Color fundus image
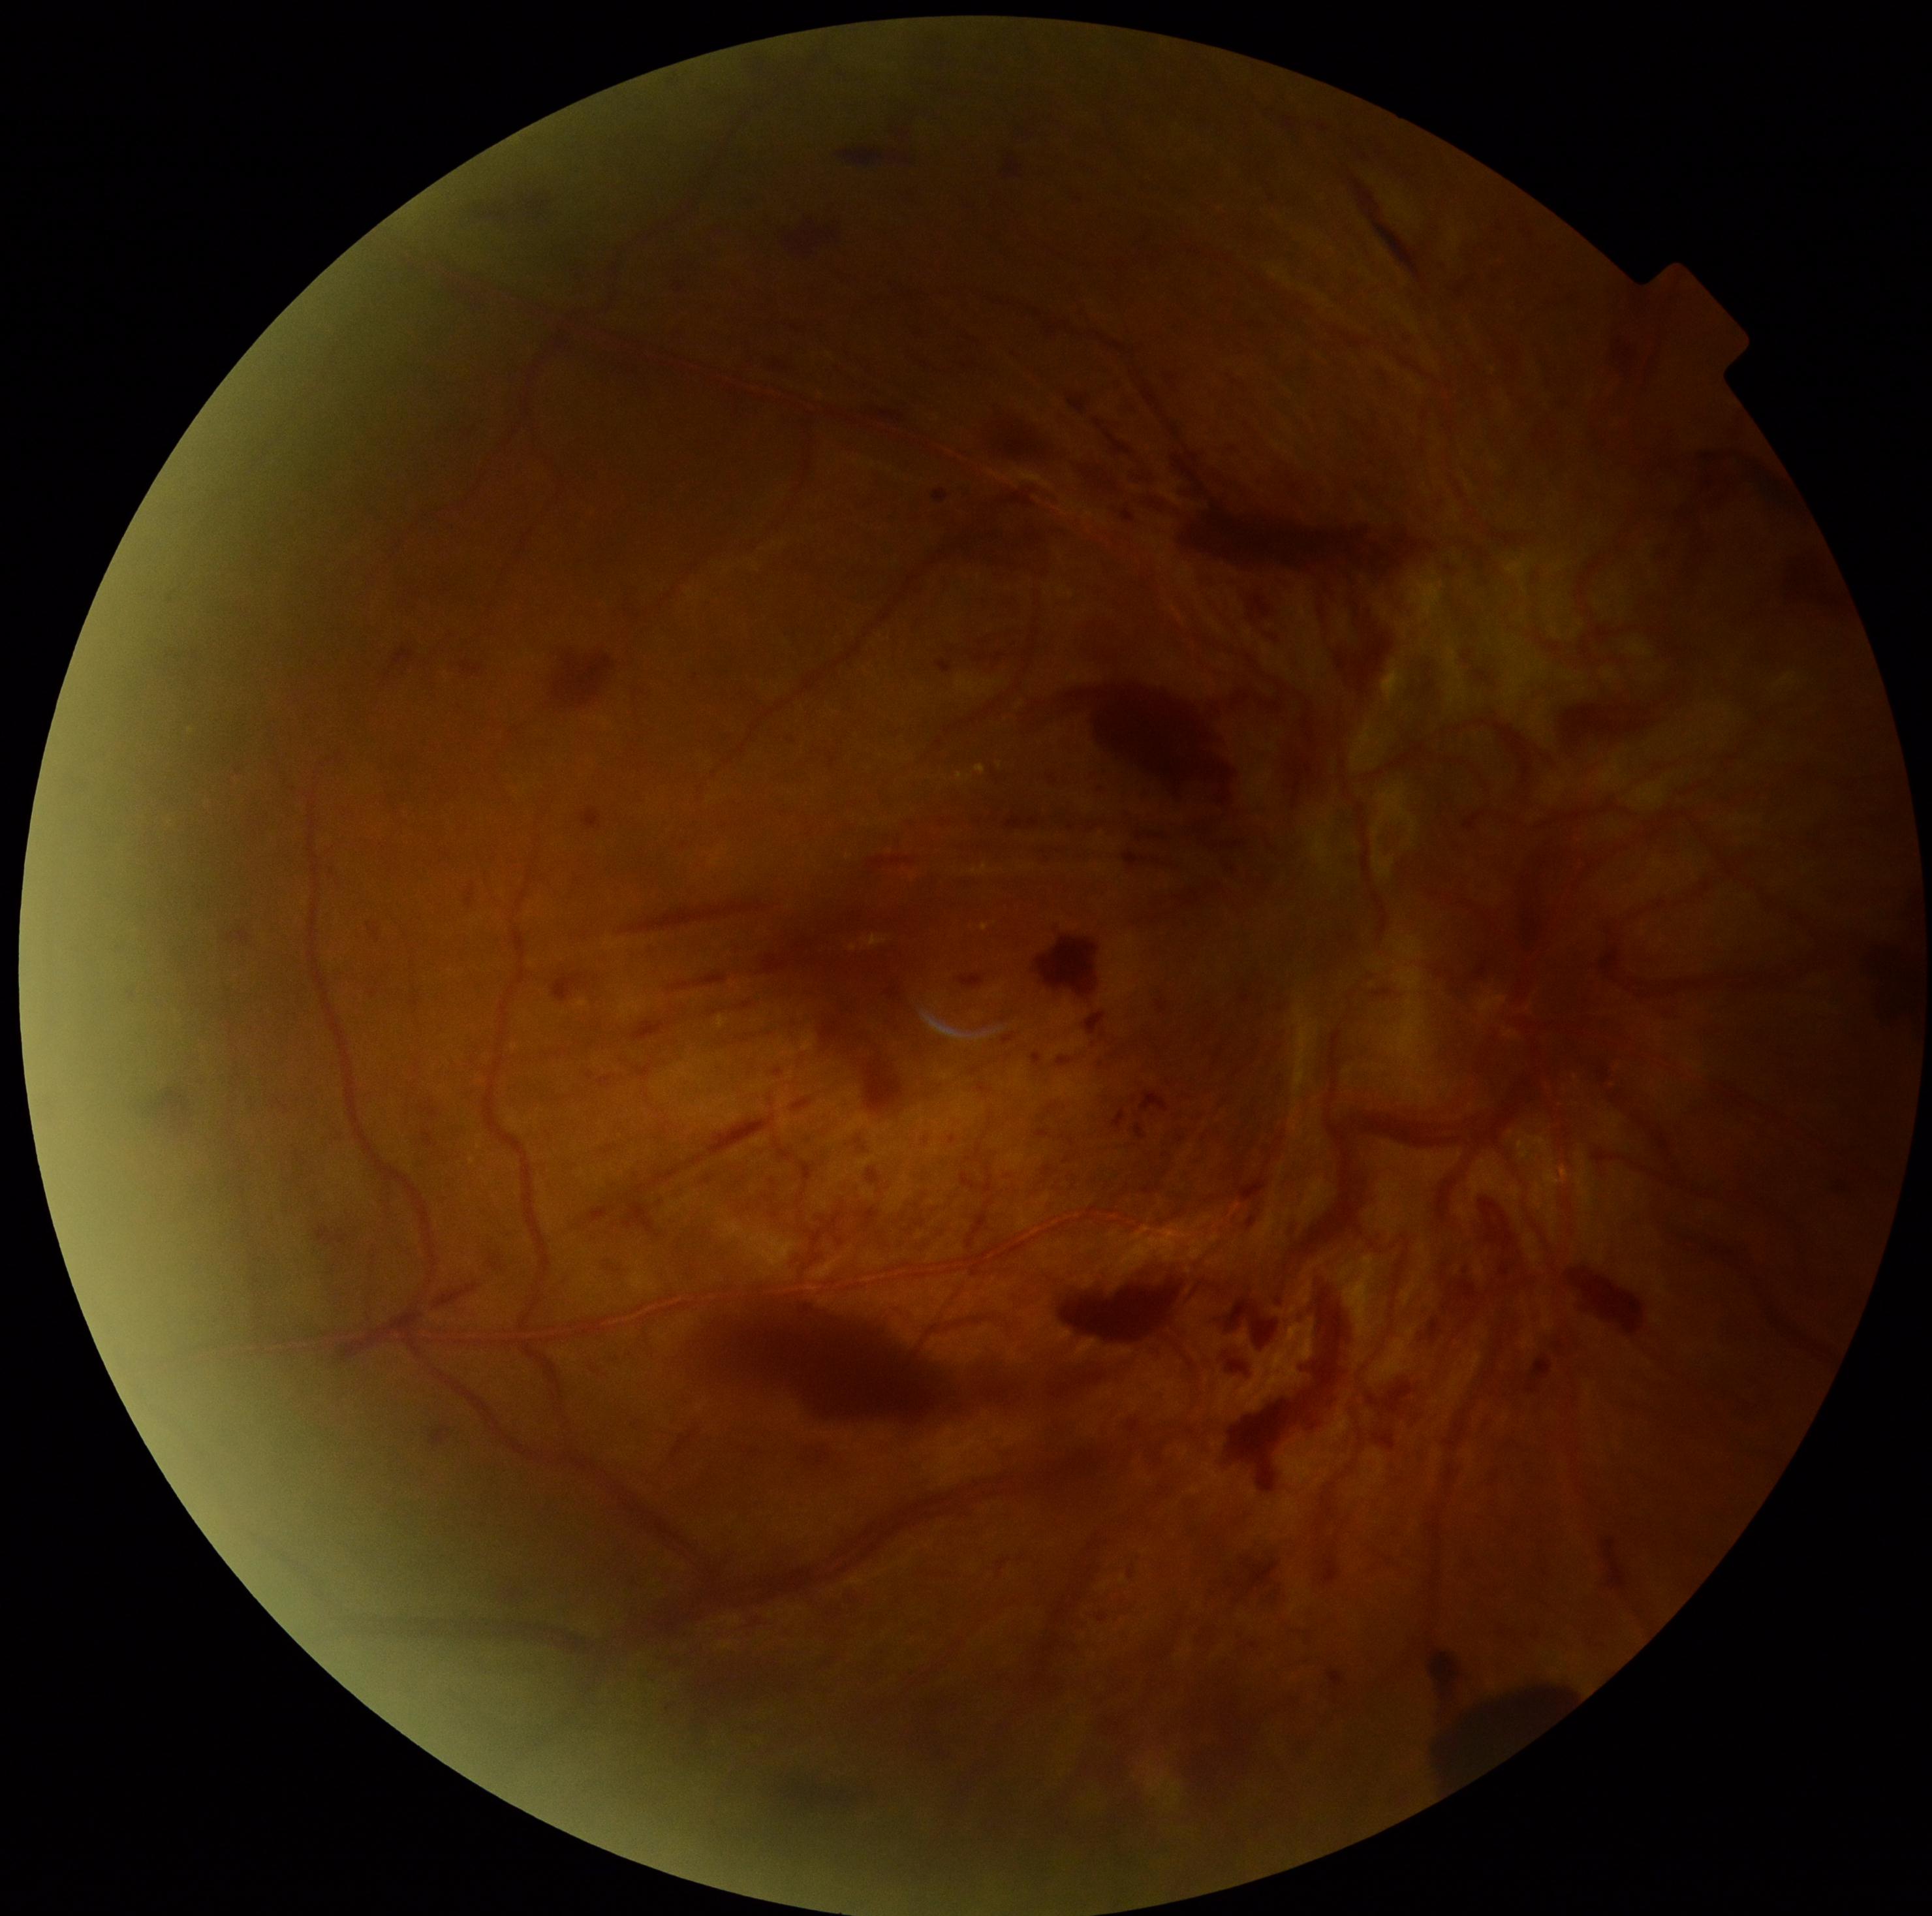 DR stage: grade 4 (PDR).